1932x1932px; color fundus image: 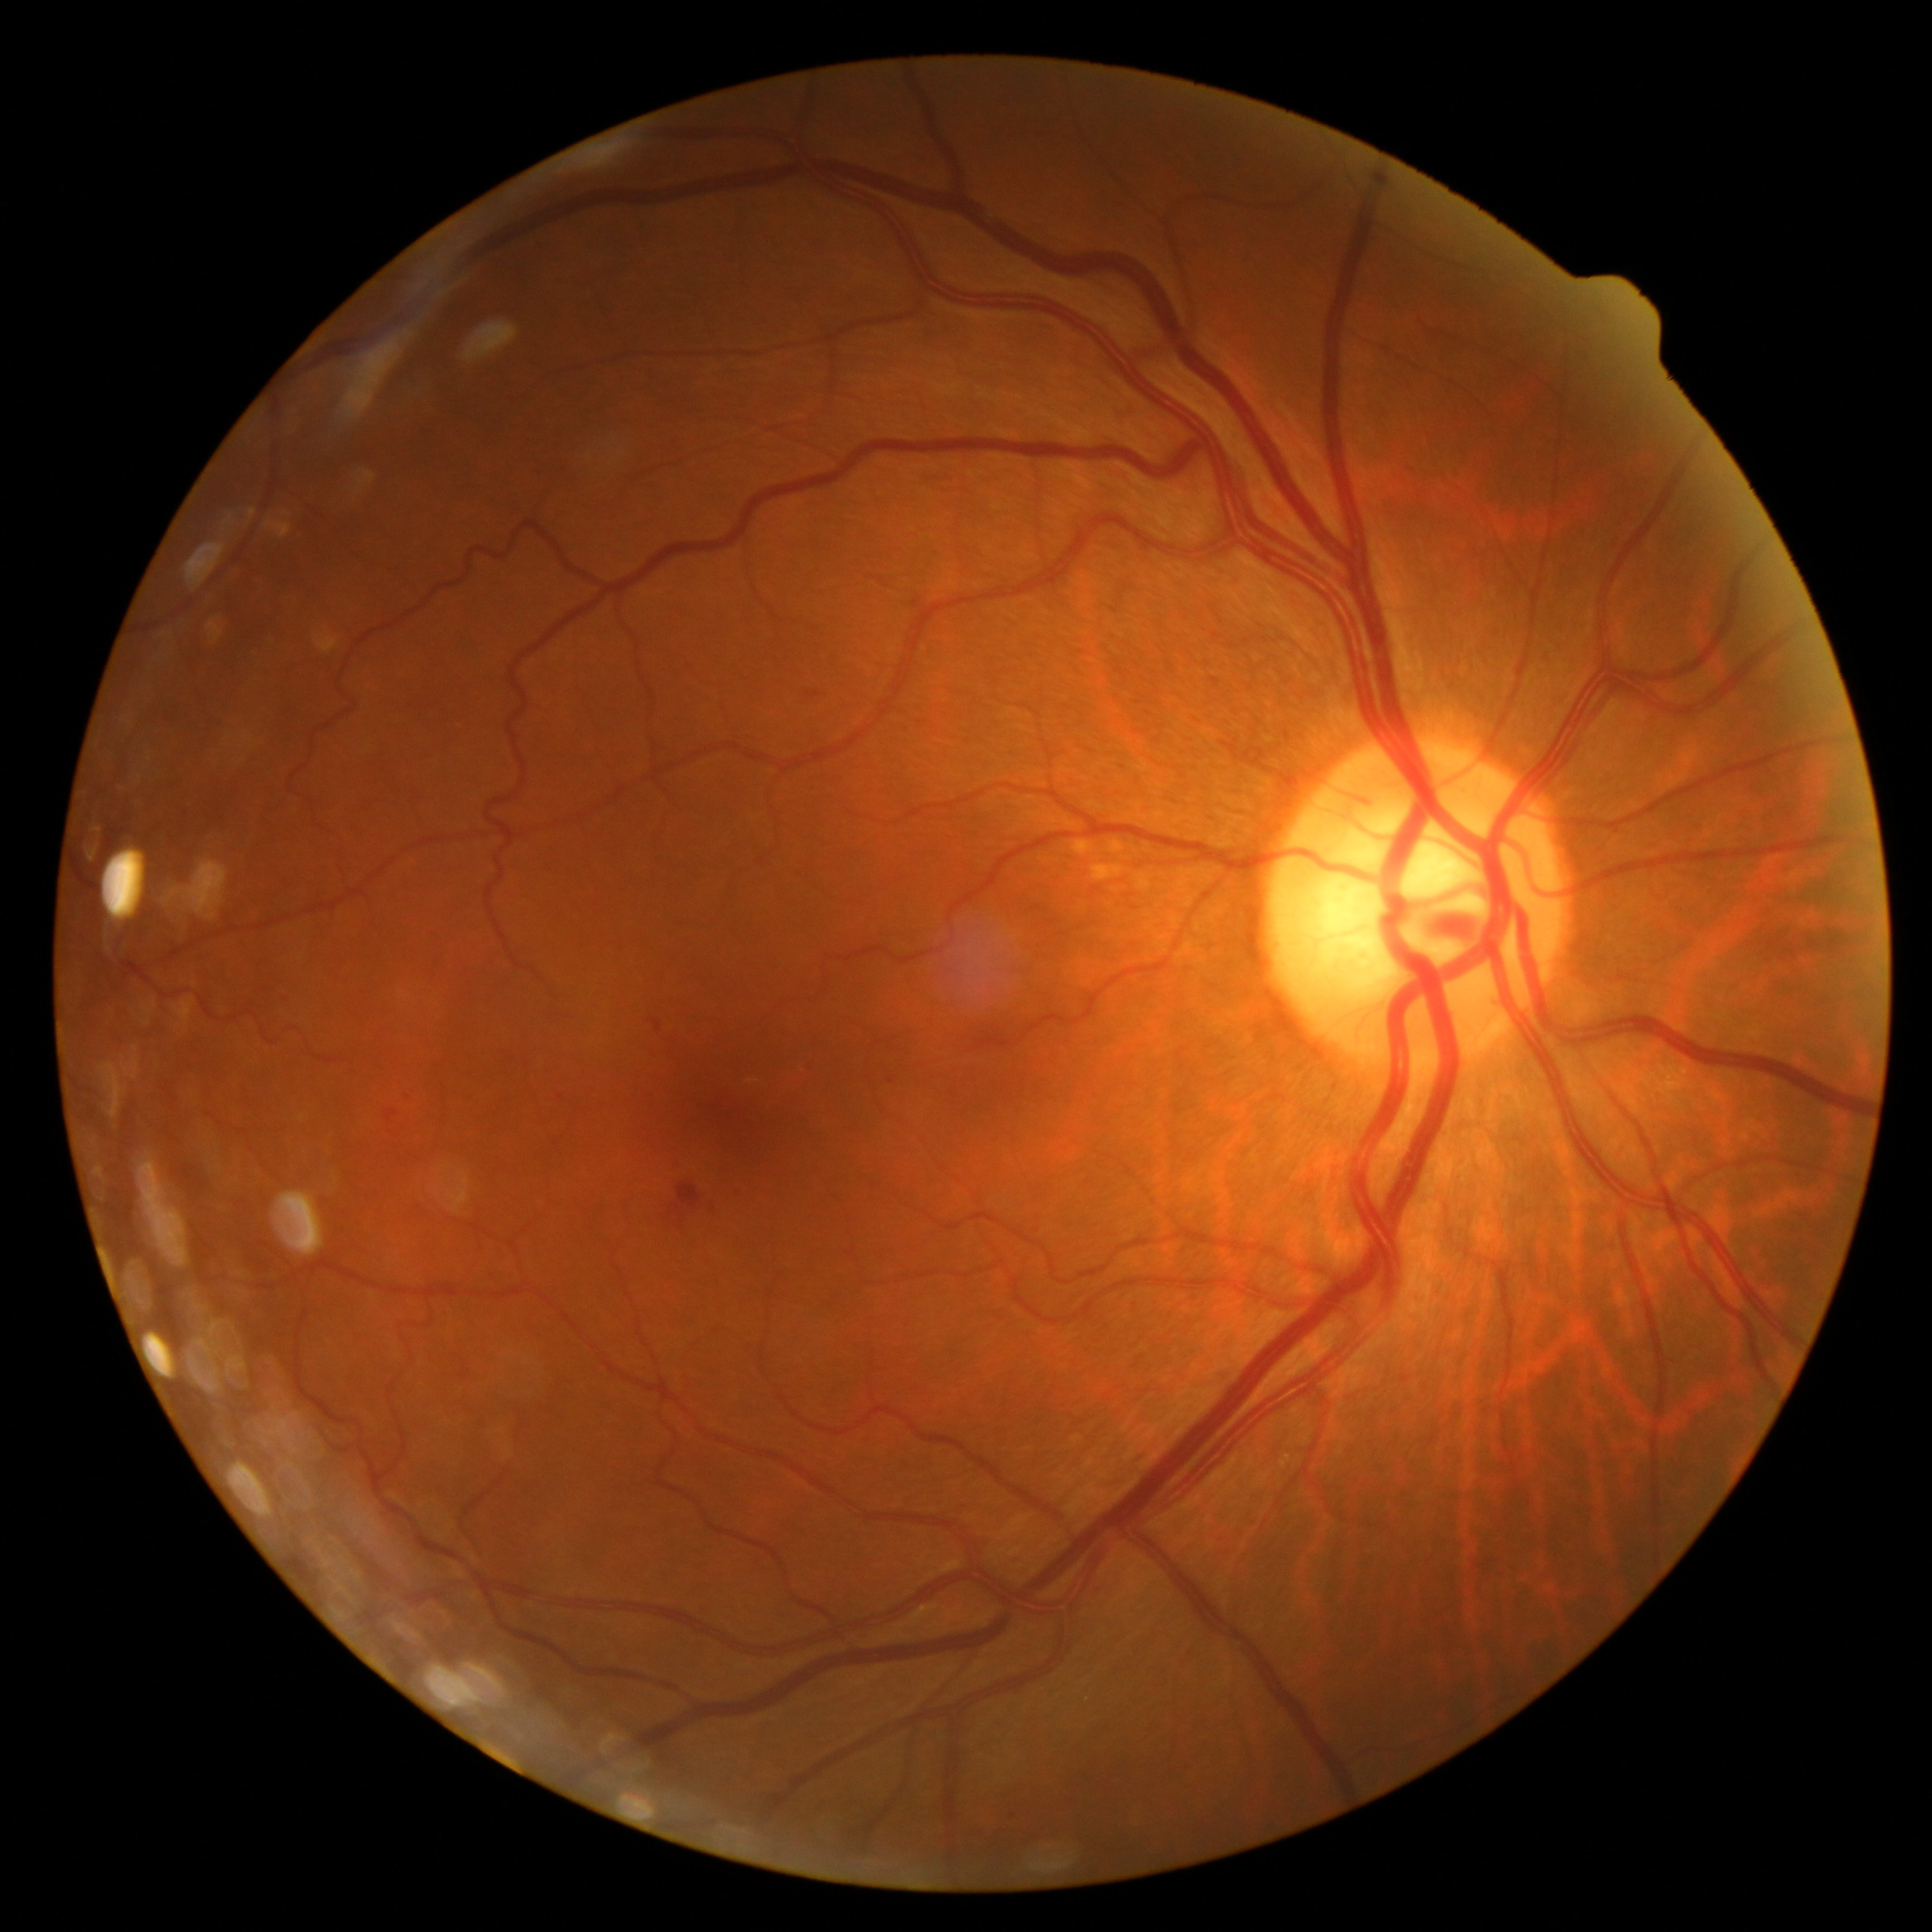

{"dr_grade":2,"dr_grade_name":"moderate NPDR","lesions":{"ma":[[399,1090,411,1105],[887,1078,895,1085]],"ma_small":[[561,1097]],"he":[[677,1182,703,1209],[648,1017,662,1034],[386,1109,399,1122],[662,1204,685,1220],[807,692,819,697]],"ex":null,"se":null}}